Infant wide-field retinal image:
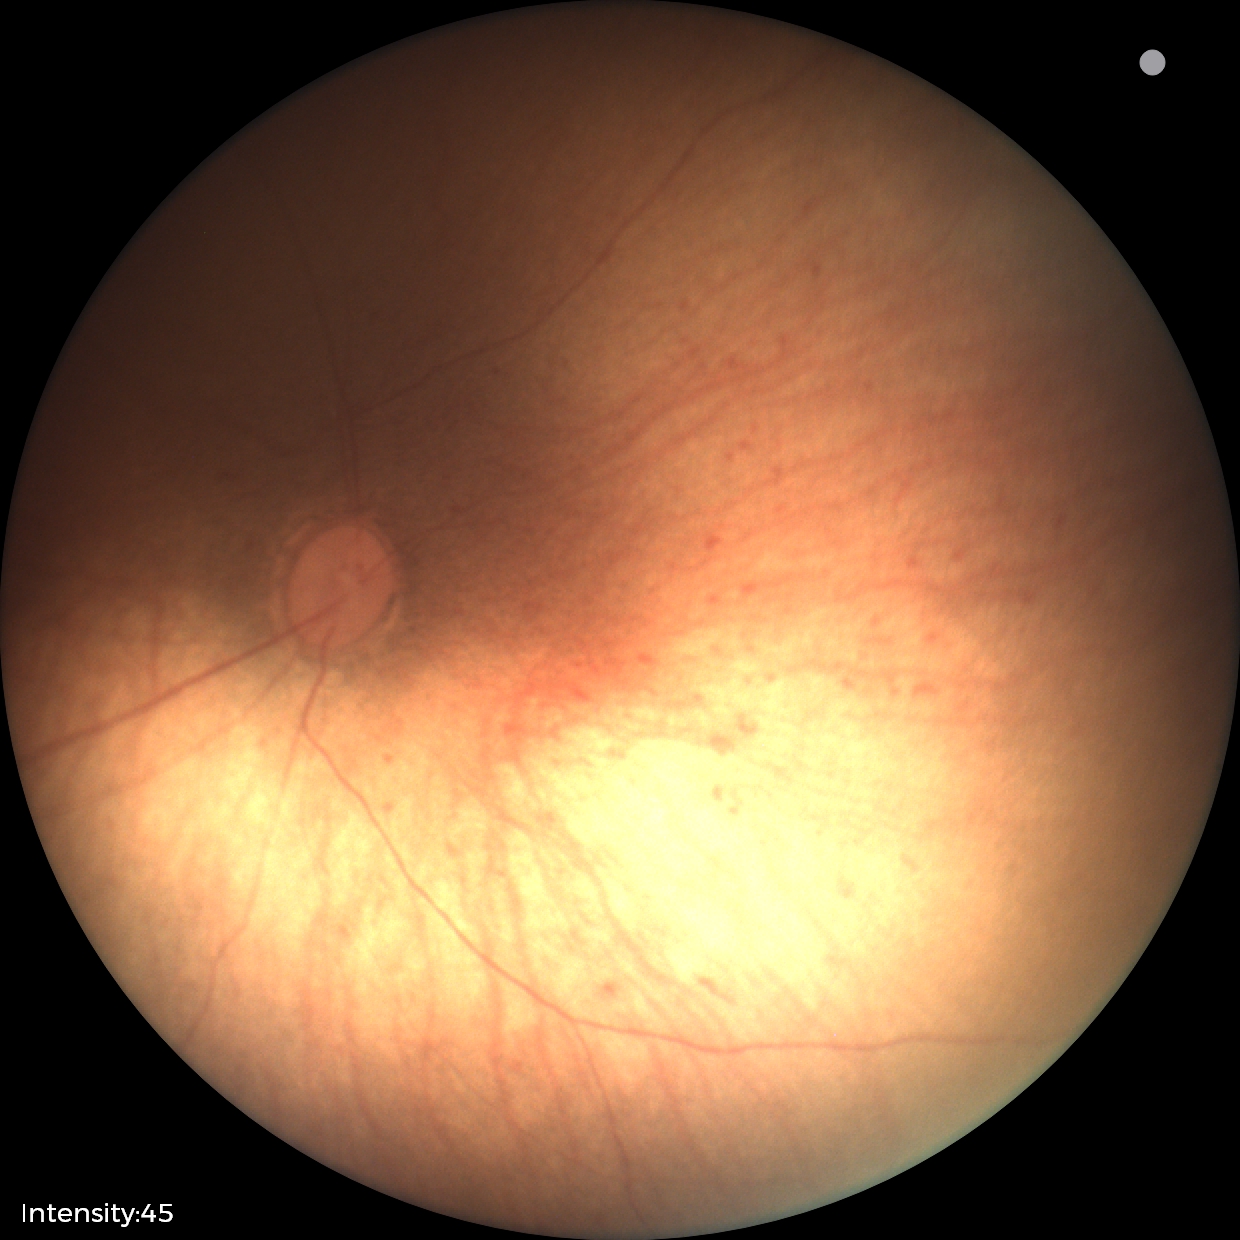

Screening: normal retinal appearance.